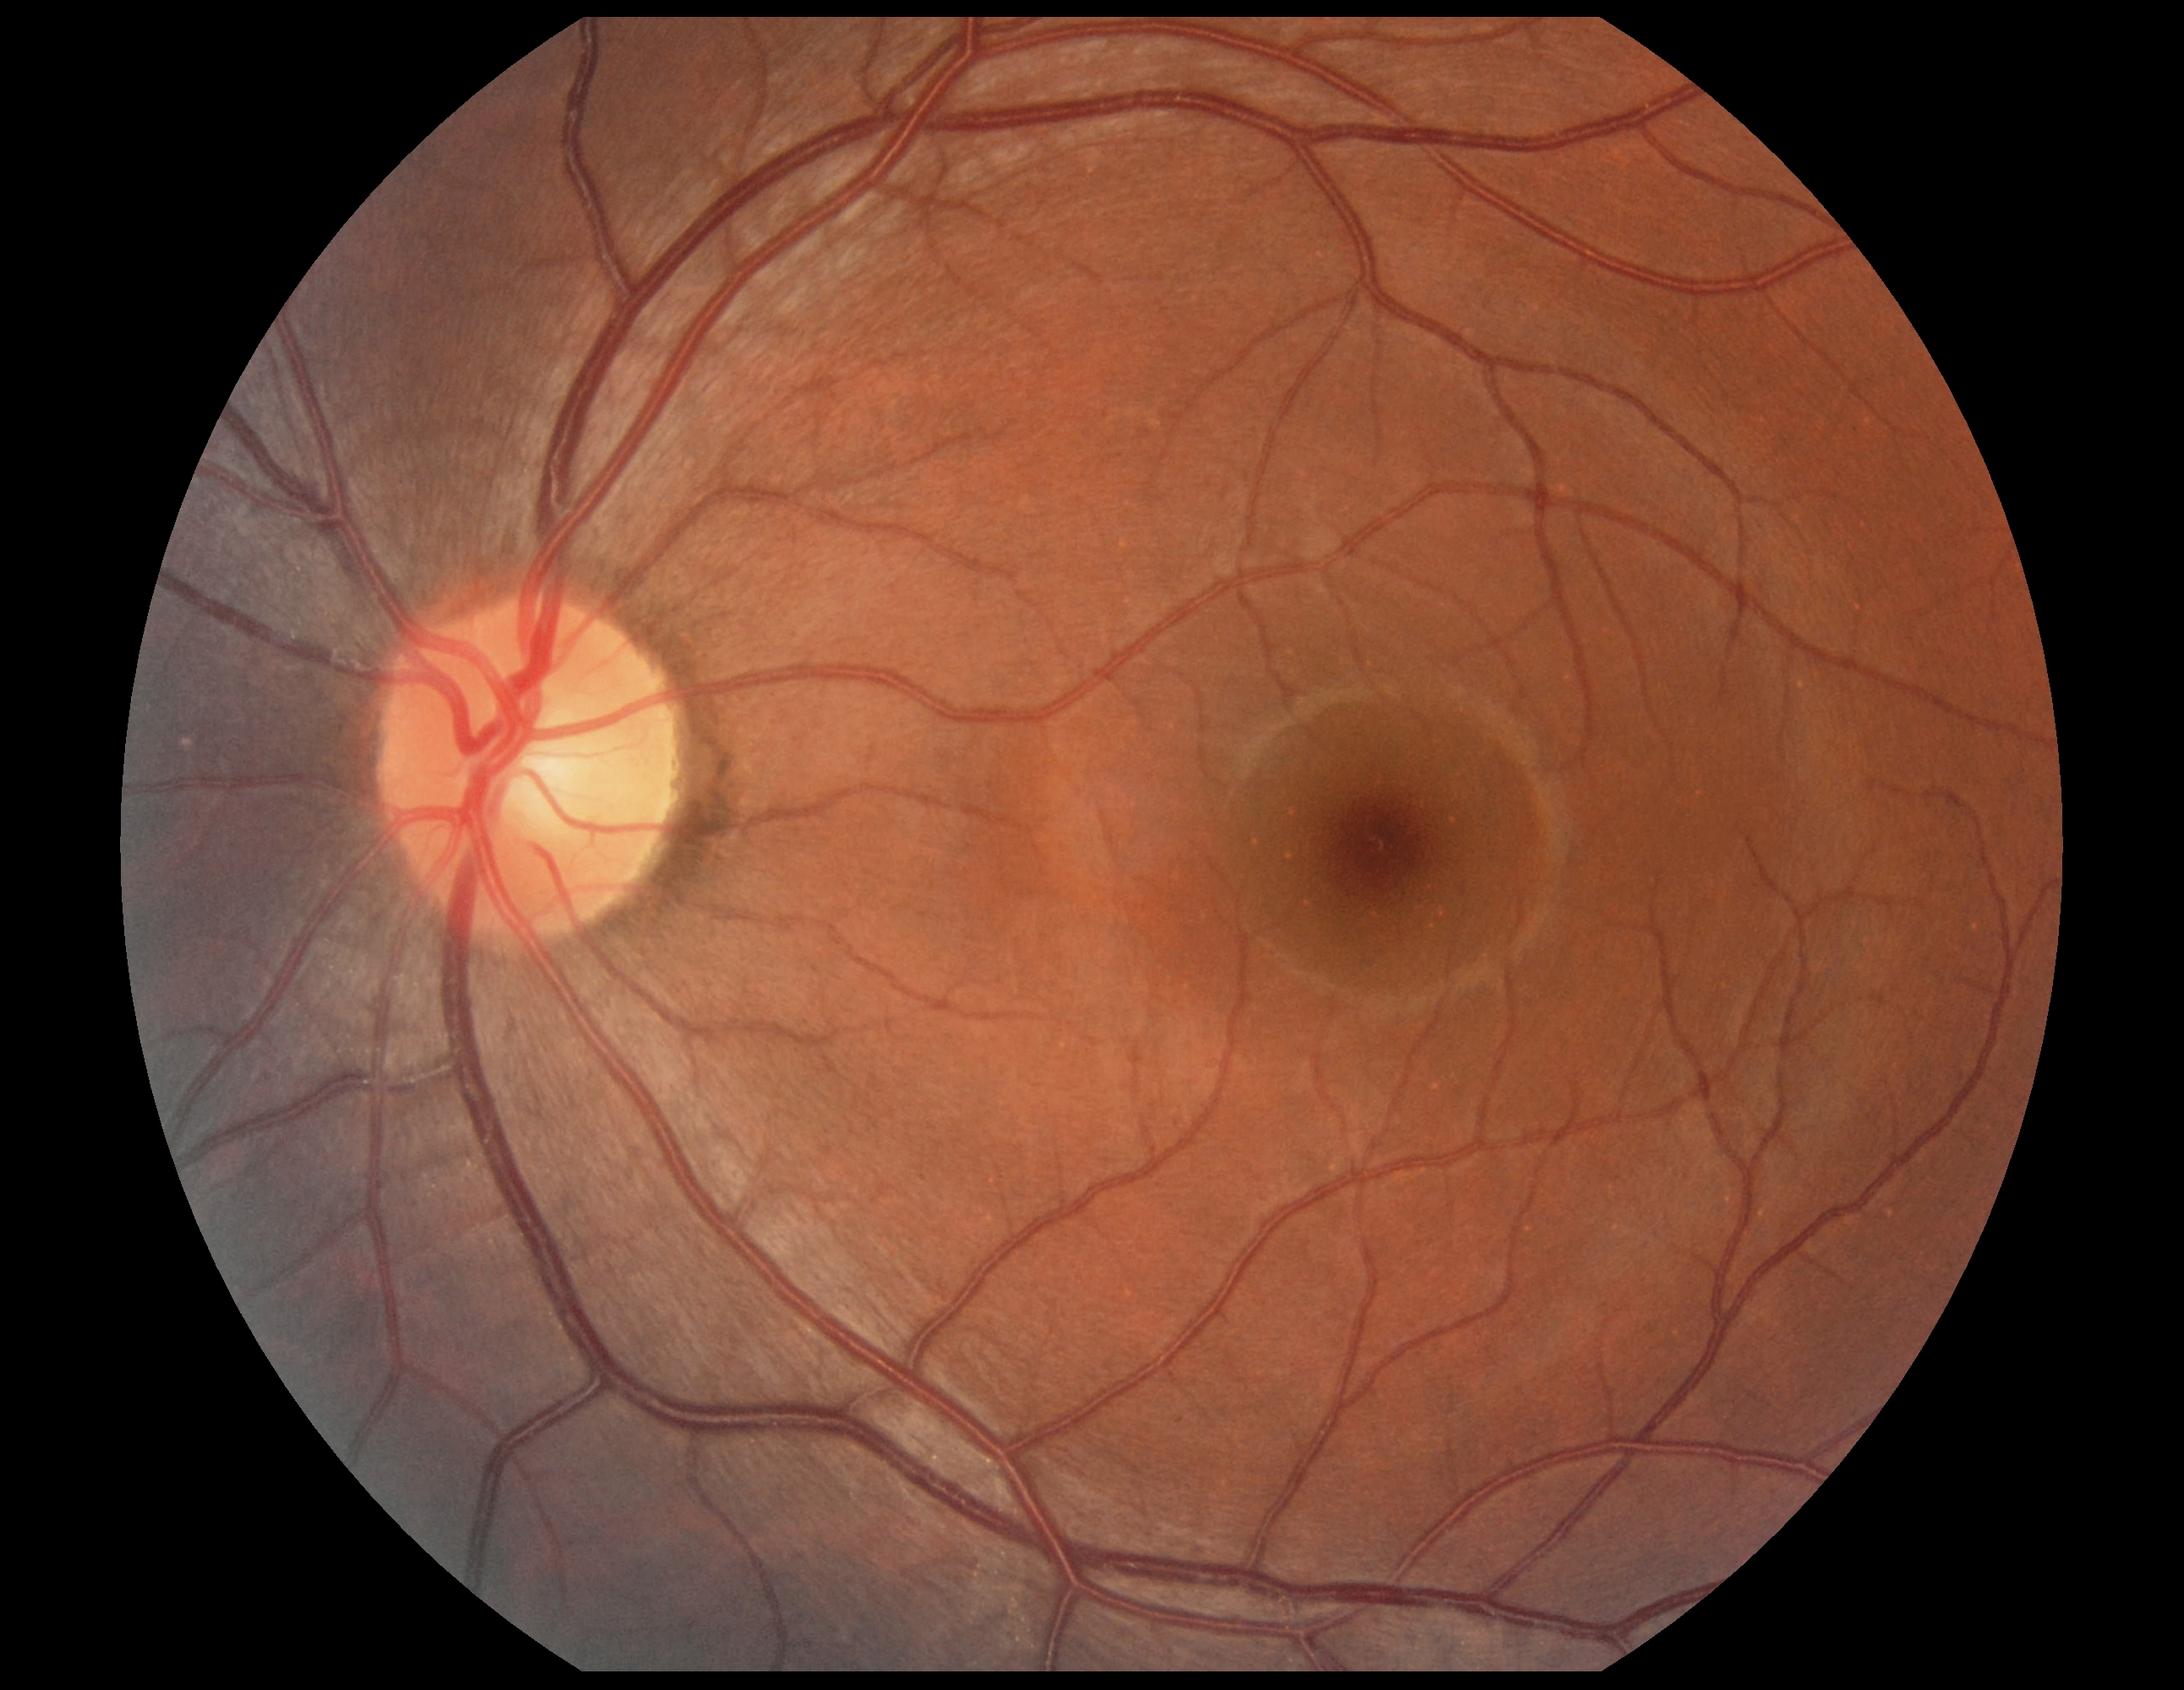

Diabetic retinopathy is 0/4 — no visible signs of diabetic retinopathy.